2352x1568. Retinal fundus photograph — 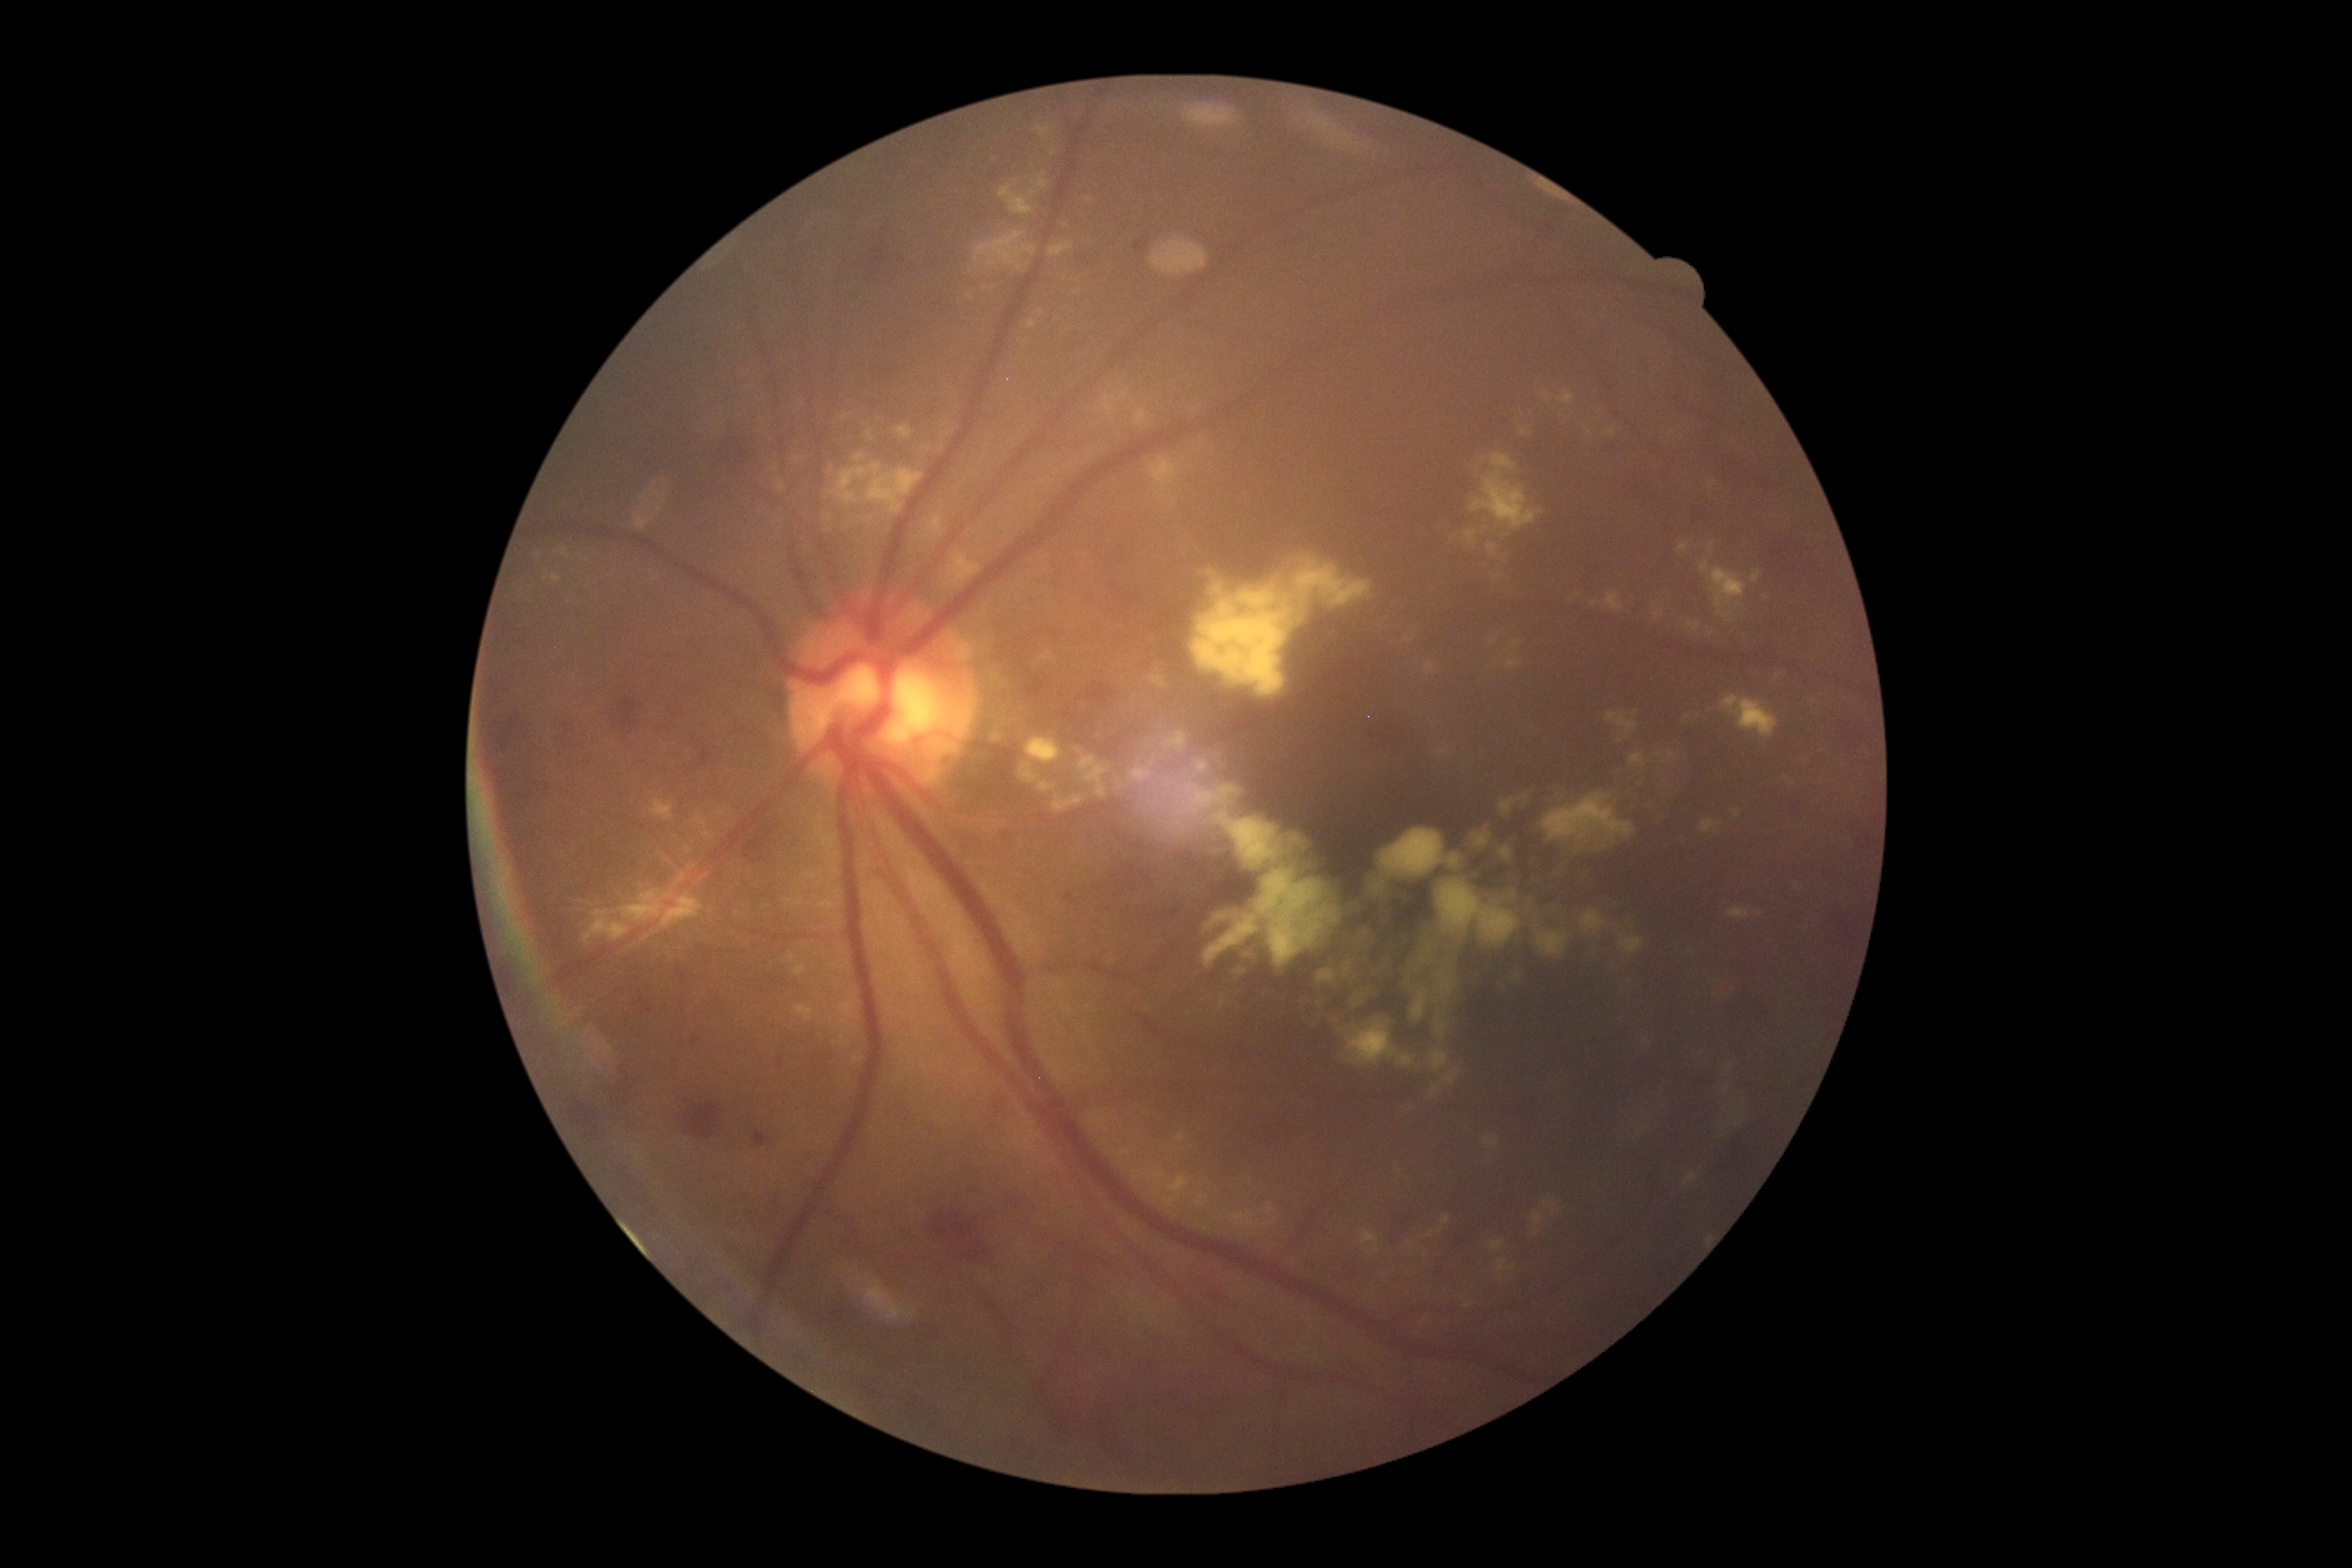 DR stage: moderate NPDR (grade 2) — more than just microaneurysms but less than severe NPDR
Selected lesions:
HEs (continued): bbox=(754, 1132, 772, 1148) | bbox=(778, 1055, 785, 1068) | bbox=(747, 1186, 796, 1237) | bbox=(707, 433, 761, 491) | bbox=(972, 1288, 1030, 1364) | bbox=(738, 816, 785, 861) | bbox=(937, 1210, 1008, 1269) | bbox=(1329, 1257, 1369, 1286) | bbox=(1240, 1108, 1309, 1150) | bbox=(1083, 680, 1124, 710) | bbox=(1736, 995, 1774, 1035) | bbox=(611, 698, 643, 743) | bbox=(556, 1059, 649, 1146) | bbox=(1126, 235, 1148, 264) | bbox=(687, 738, 712, 769) | bbox=(1077, 246, 1108, 279) | bbox=(487, 716, 553, 810) | bbox=(1384, 1208, 1426, 1251)
Additional small HEs near [x=847, y=1243]
EXs (continued): bbox=(794, 966, 807, 977) | bbox=(1353, 1213, 1458, 1288) | bbox=(651, 799, 674, 821) | bbox=(1732, 810, 1743, 819) | bbox=(1148, 672, 1168, 689) | bbox=(1262, 1204, 1277, 1219) | bbox=(1524, 1191, 1565, 1244) | bbox=(1093, 387, 1384, 700) | bbox=(1177, 1133, 1184, 1144) | bbox=(1037, 309, 1044, 317) | bbox=(790, 406, 963, 549) | bbox=(1028, 318, 1039, 329) | bbox=(1195, 1197, 1208, 1210)
Additional small EXs near [x=546, y=580]